FOV: 45 degrees — 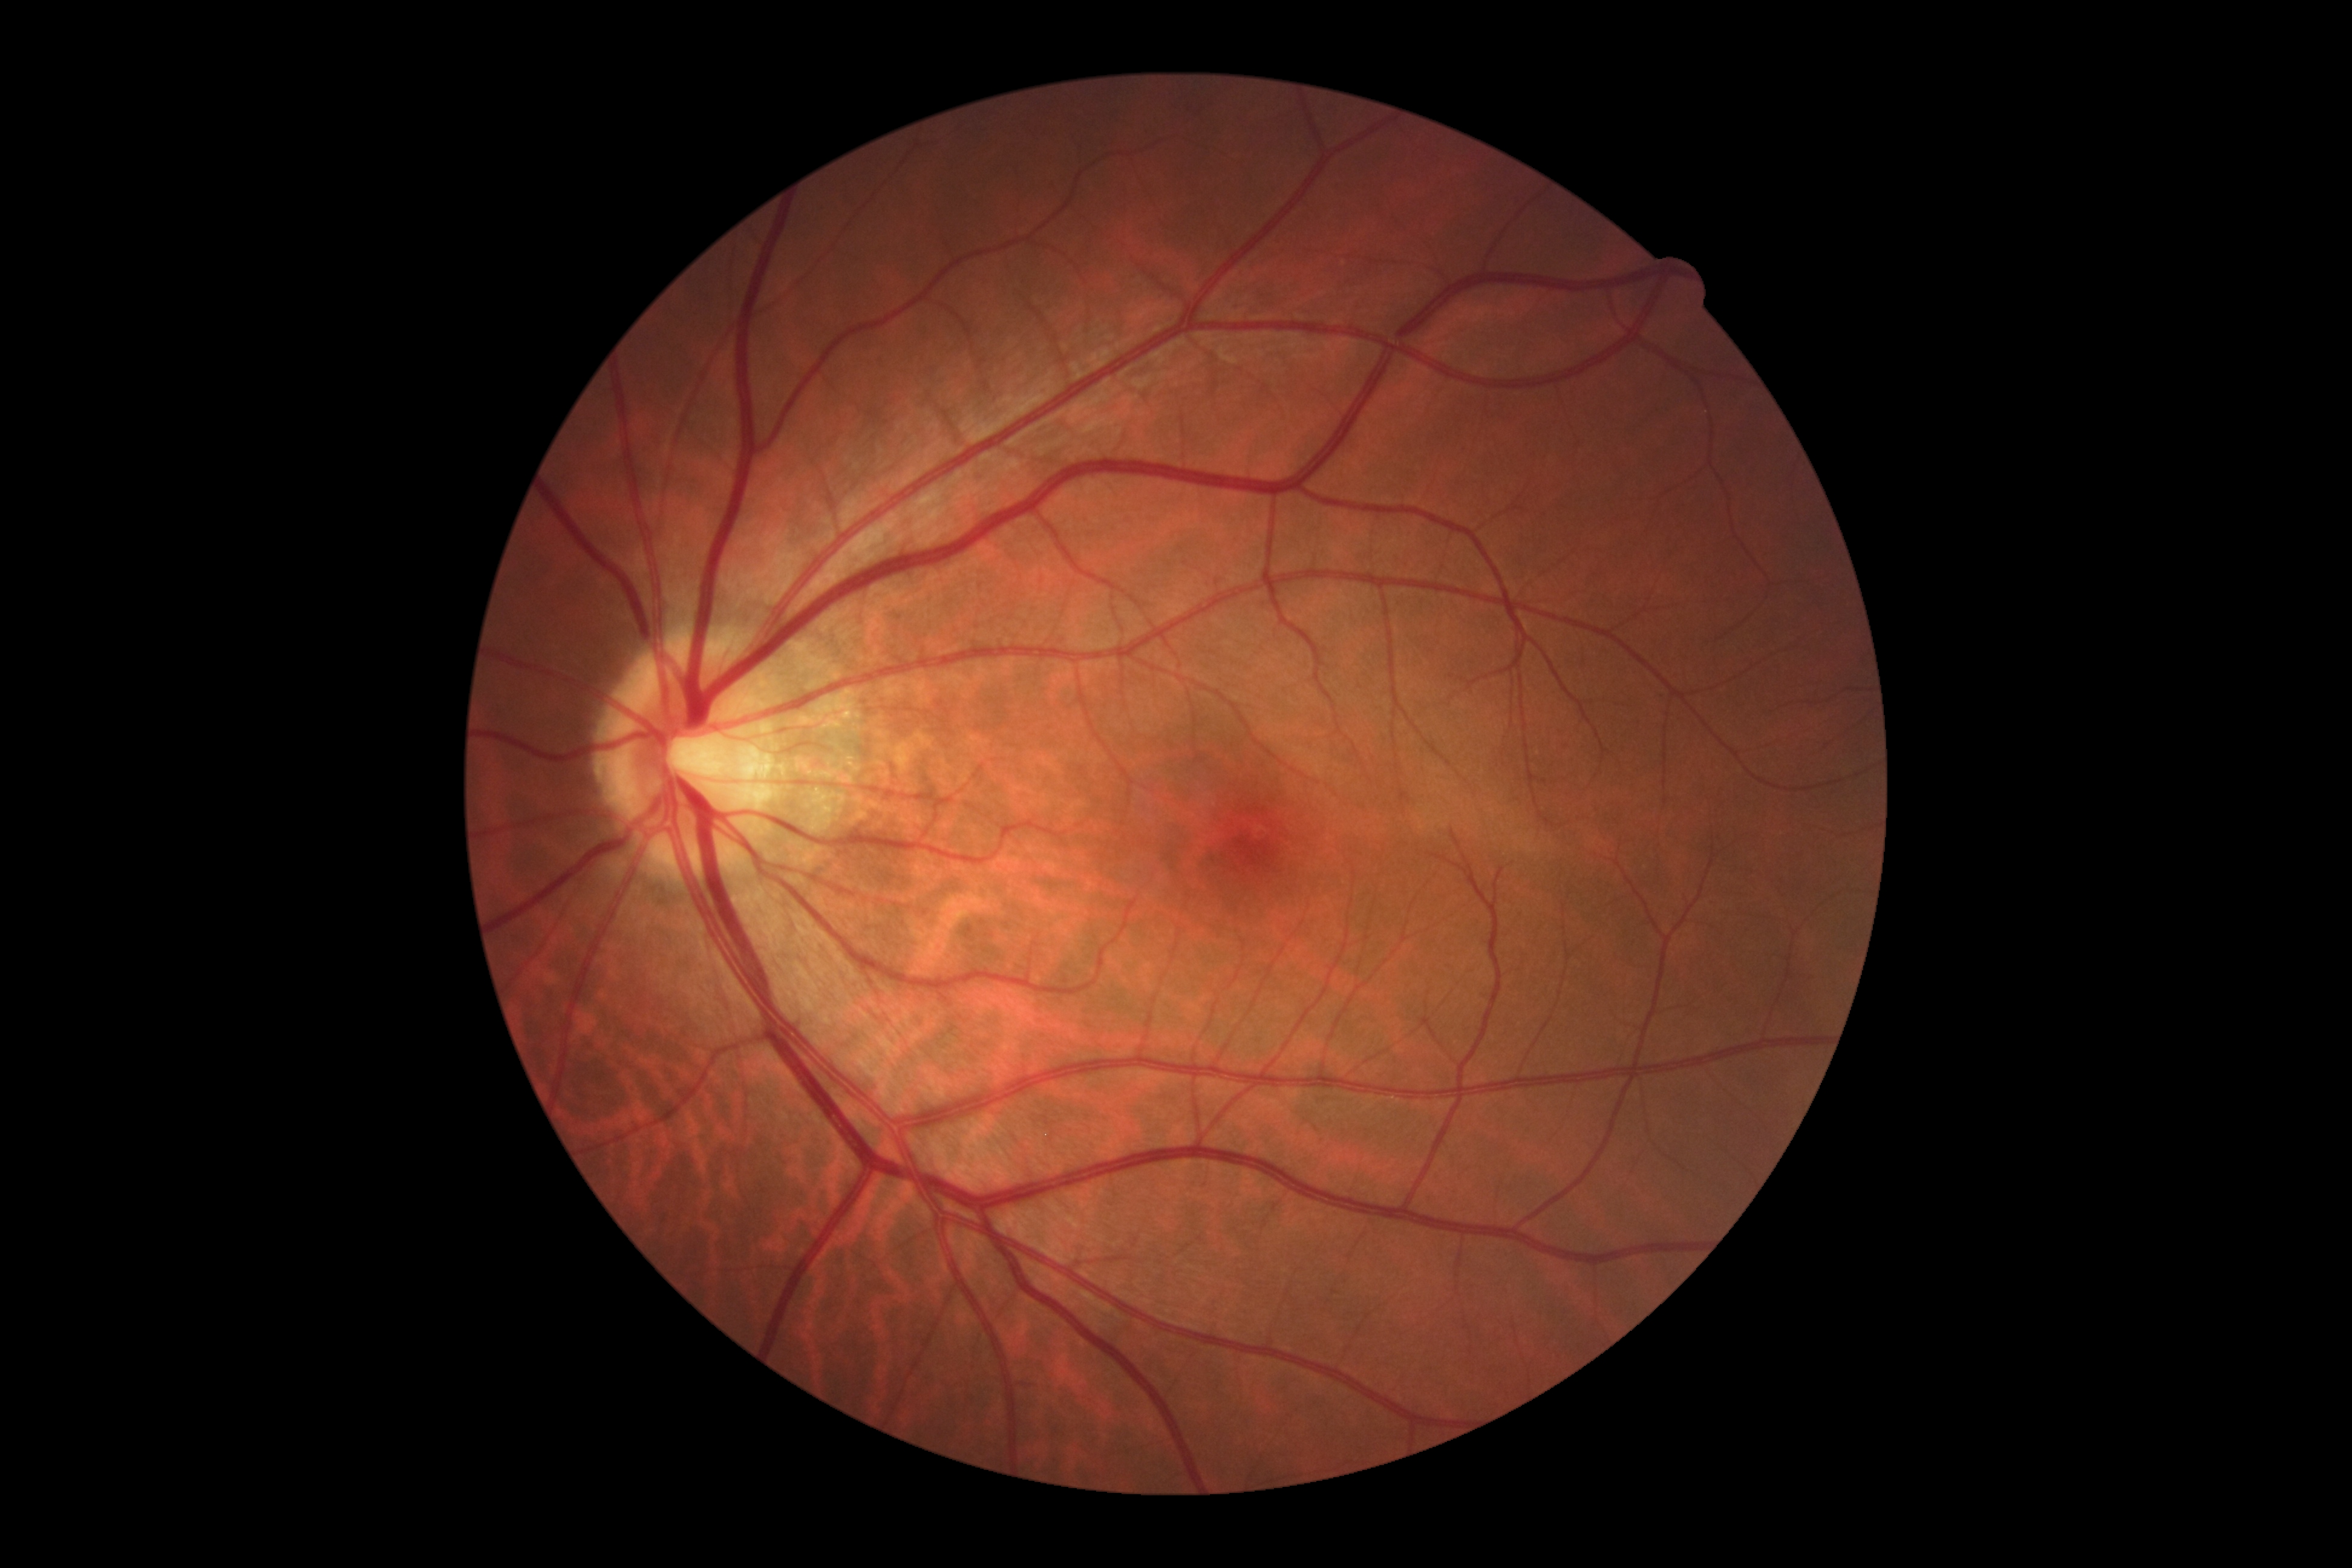
DR stage: grade 0 (no apparent retinopathy).